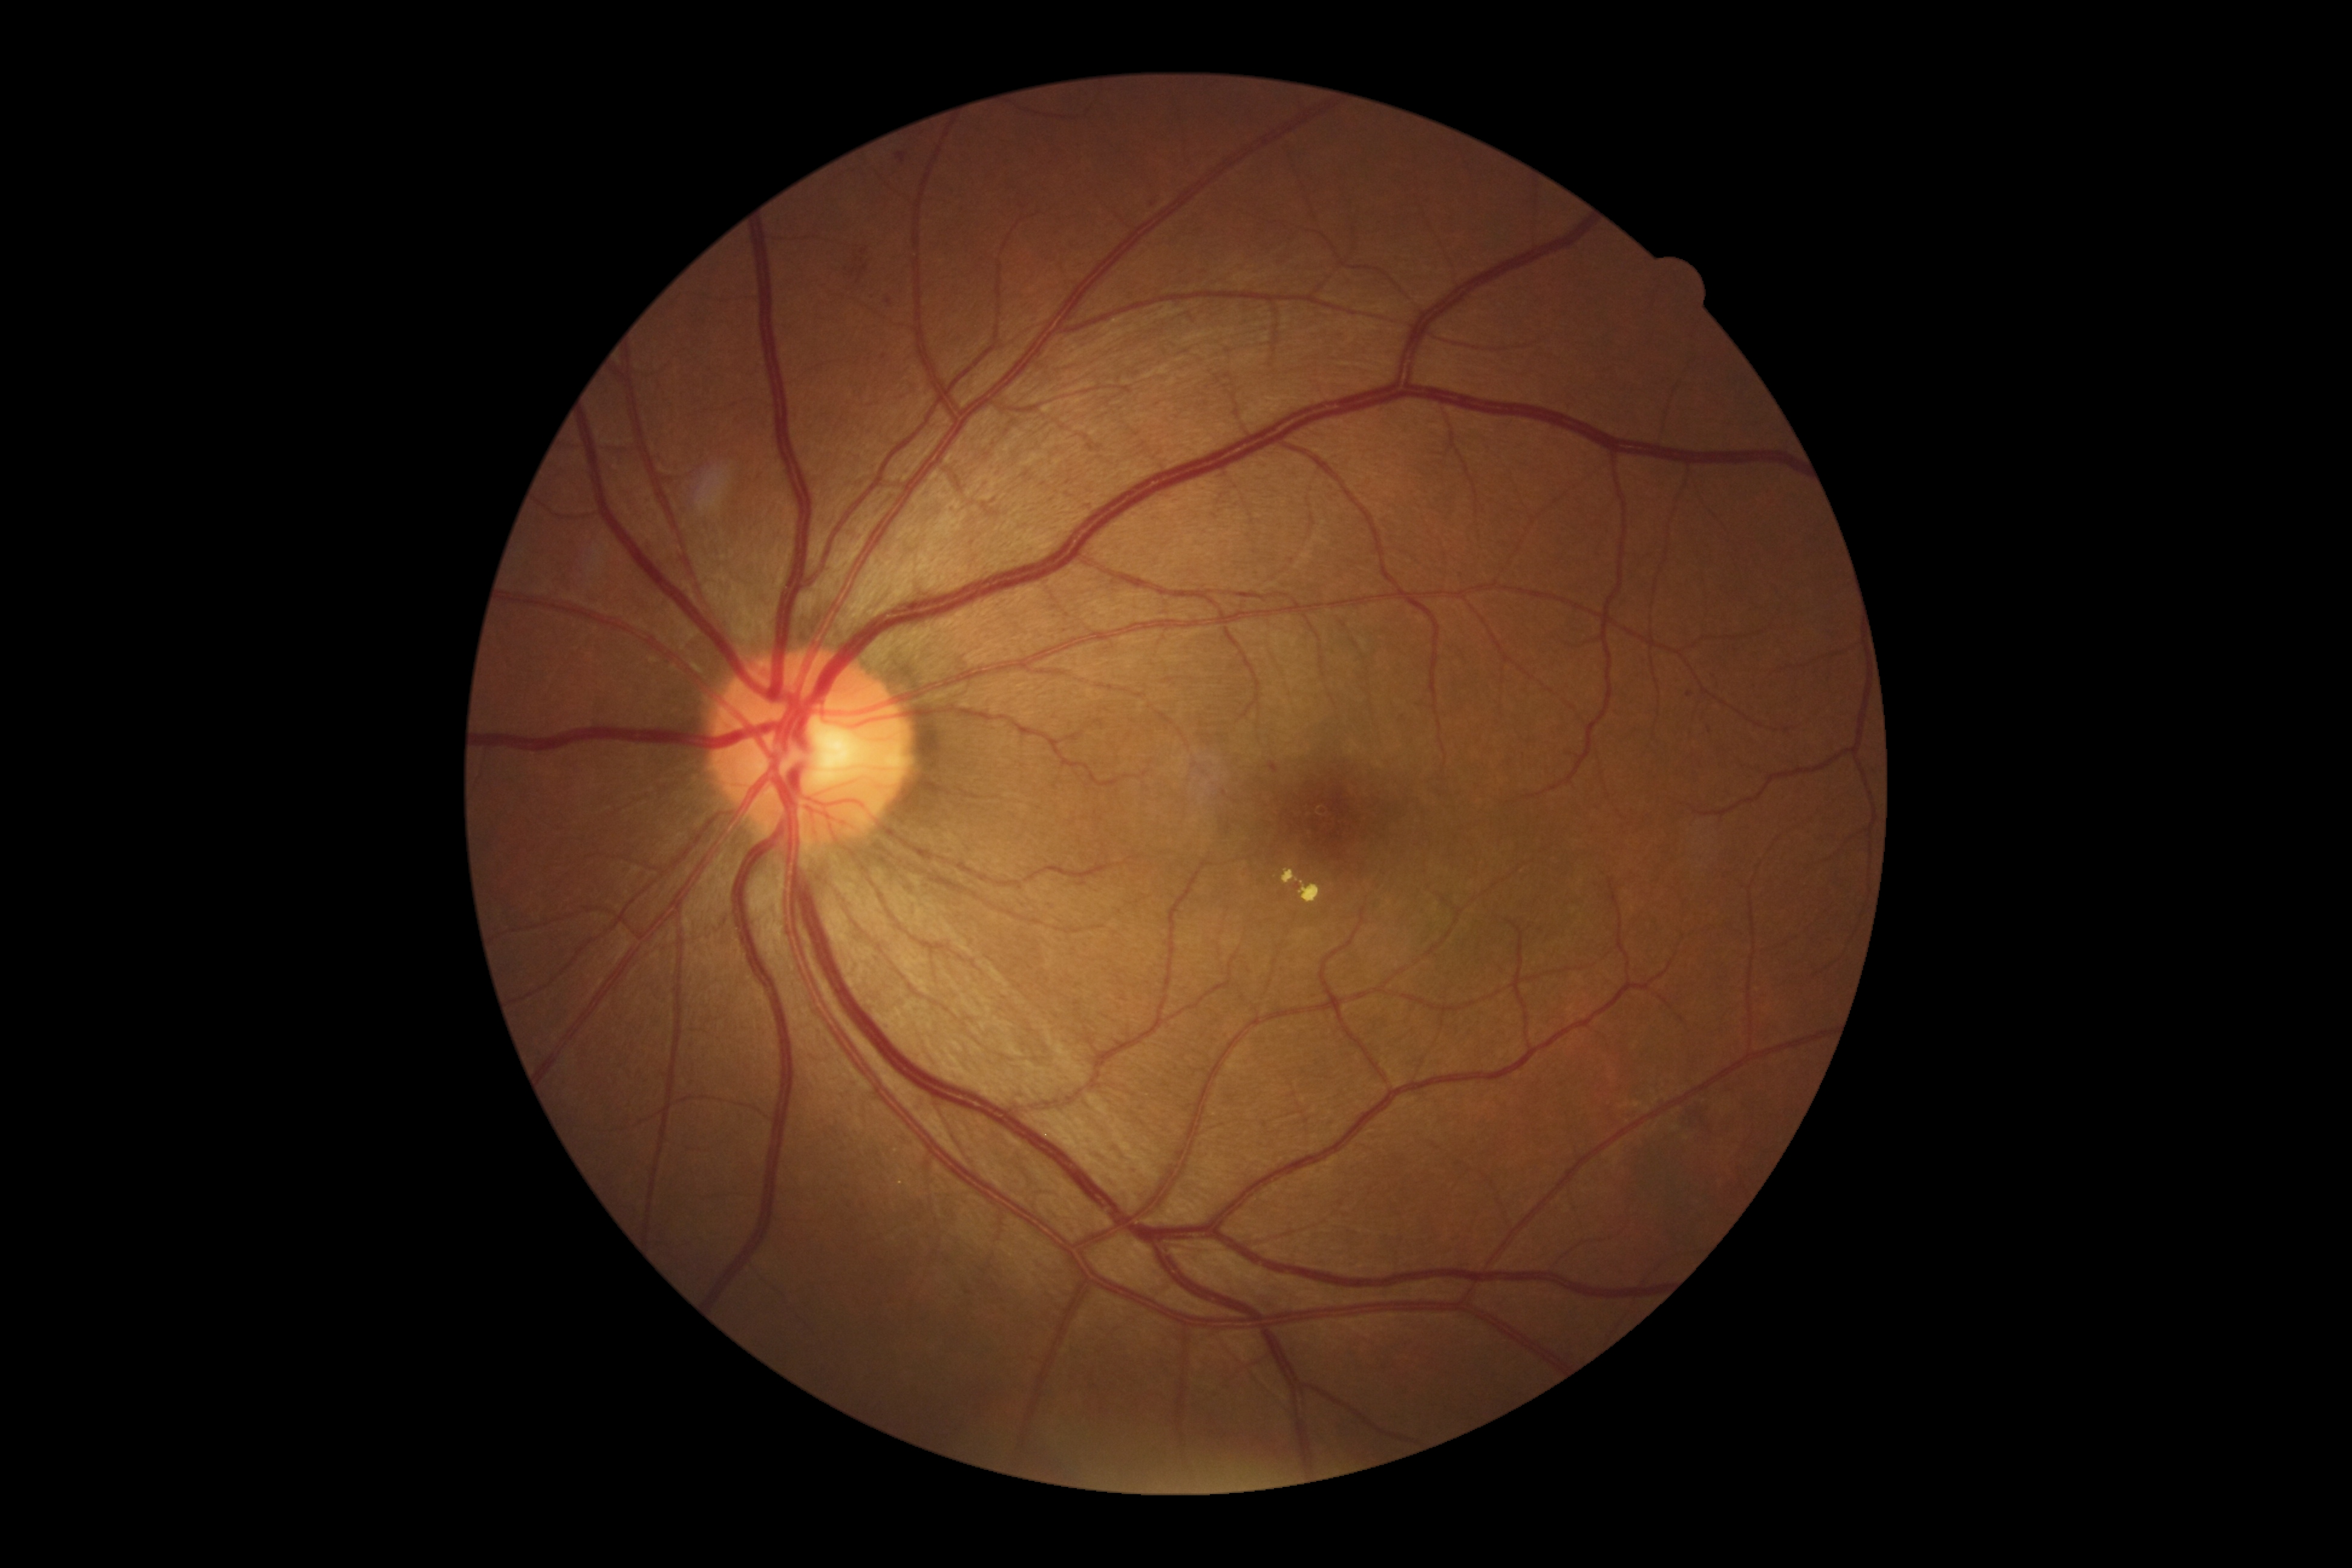
retinopathy: grade 2 (moderate NPDR) — more than just microaneurysms but less than severe NPDR; DR class: non-proliferative diabetic retinopathy.